CFP — 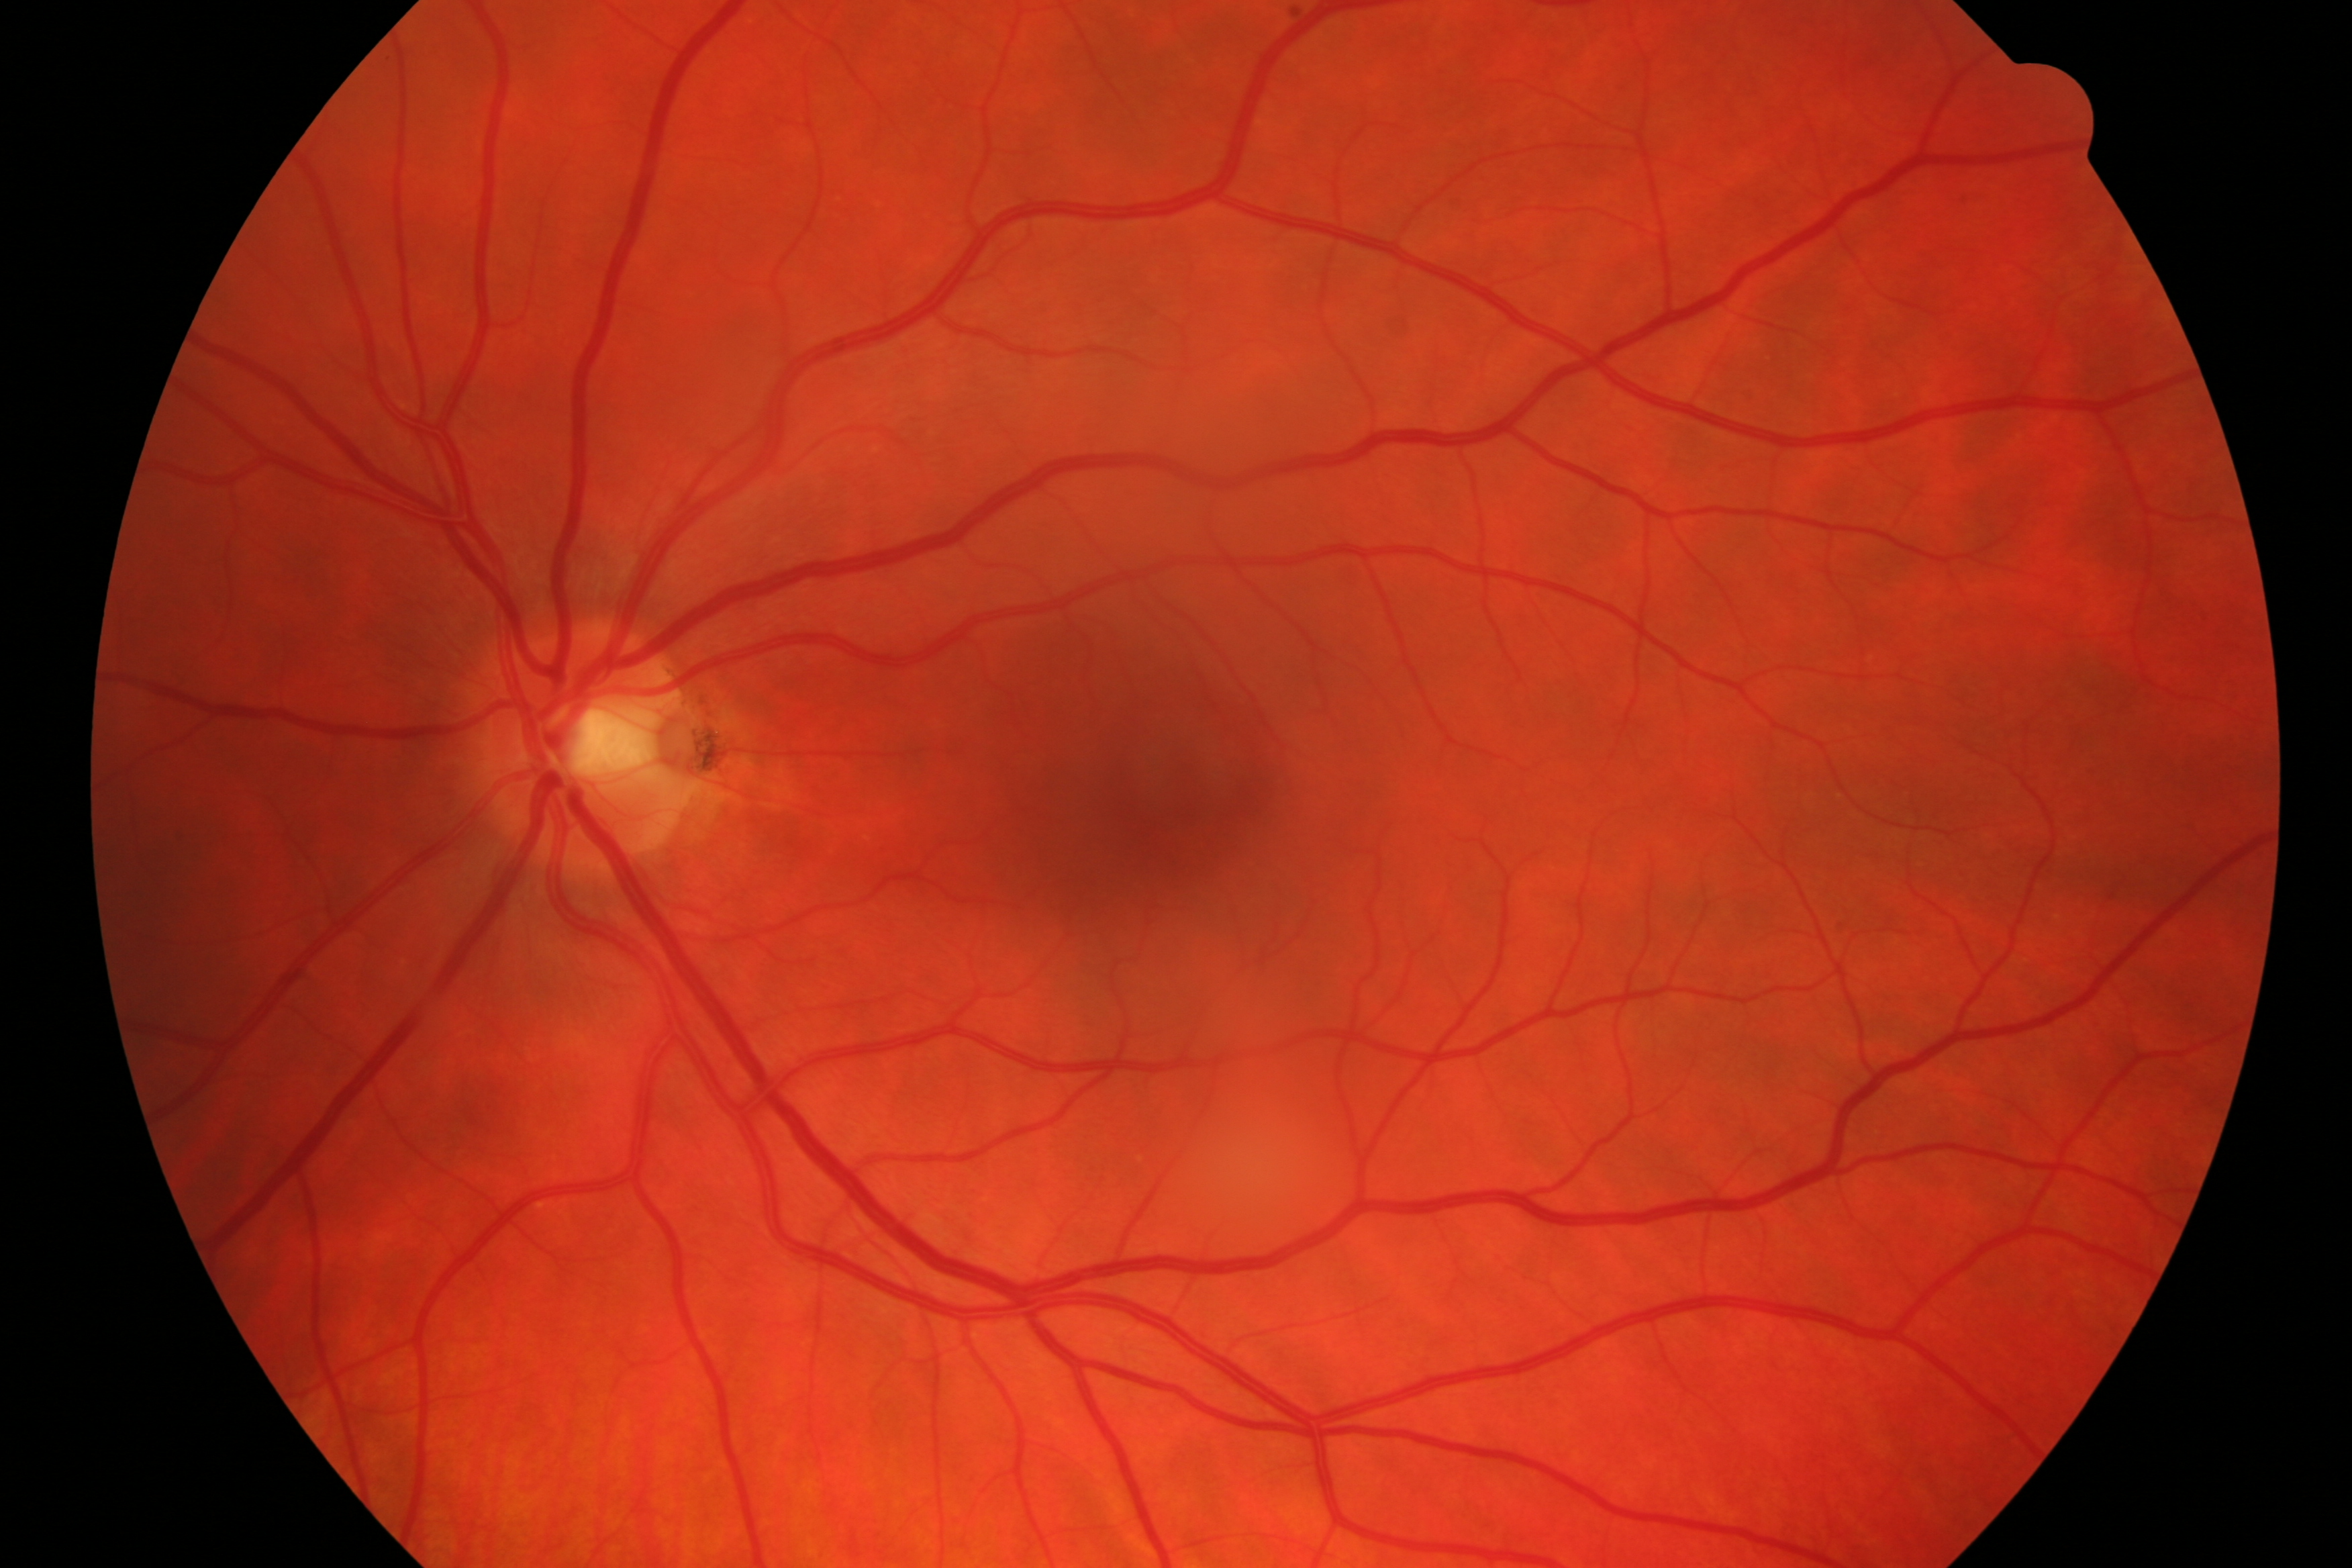
Impression: glaucomatous damage.